1932 by 1932 pixels; color fundus photograph.
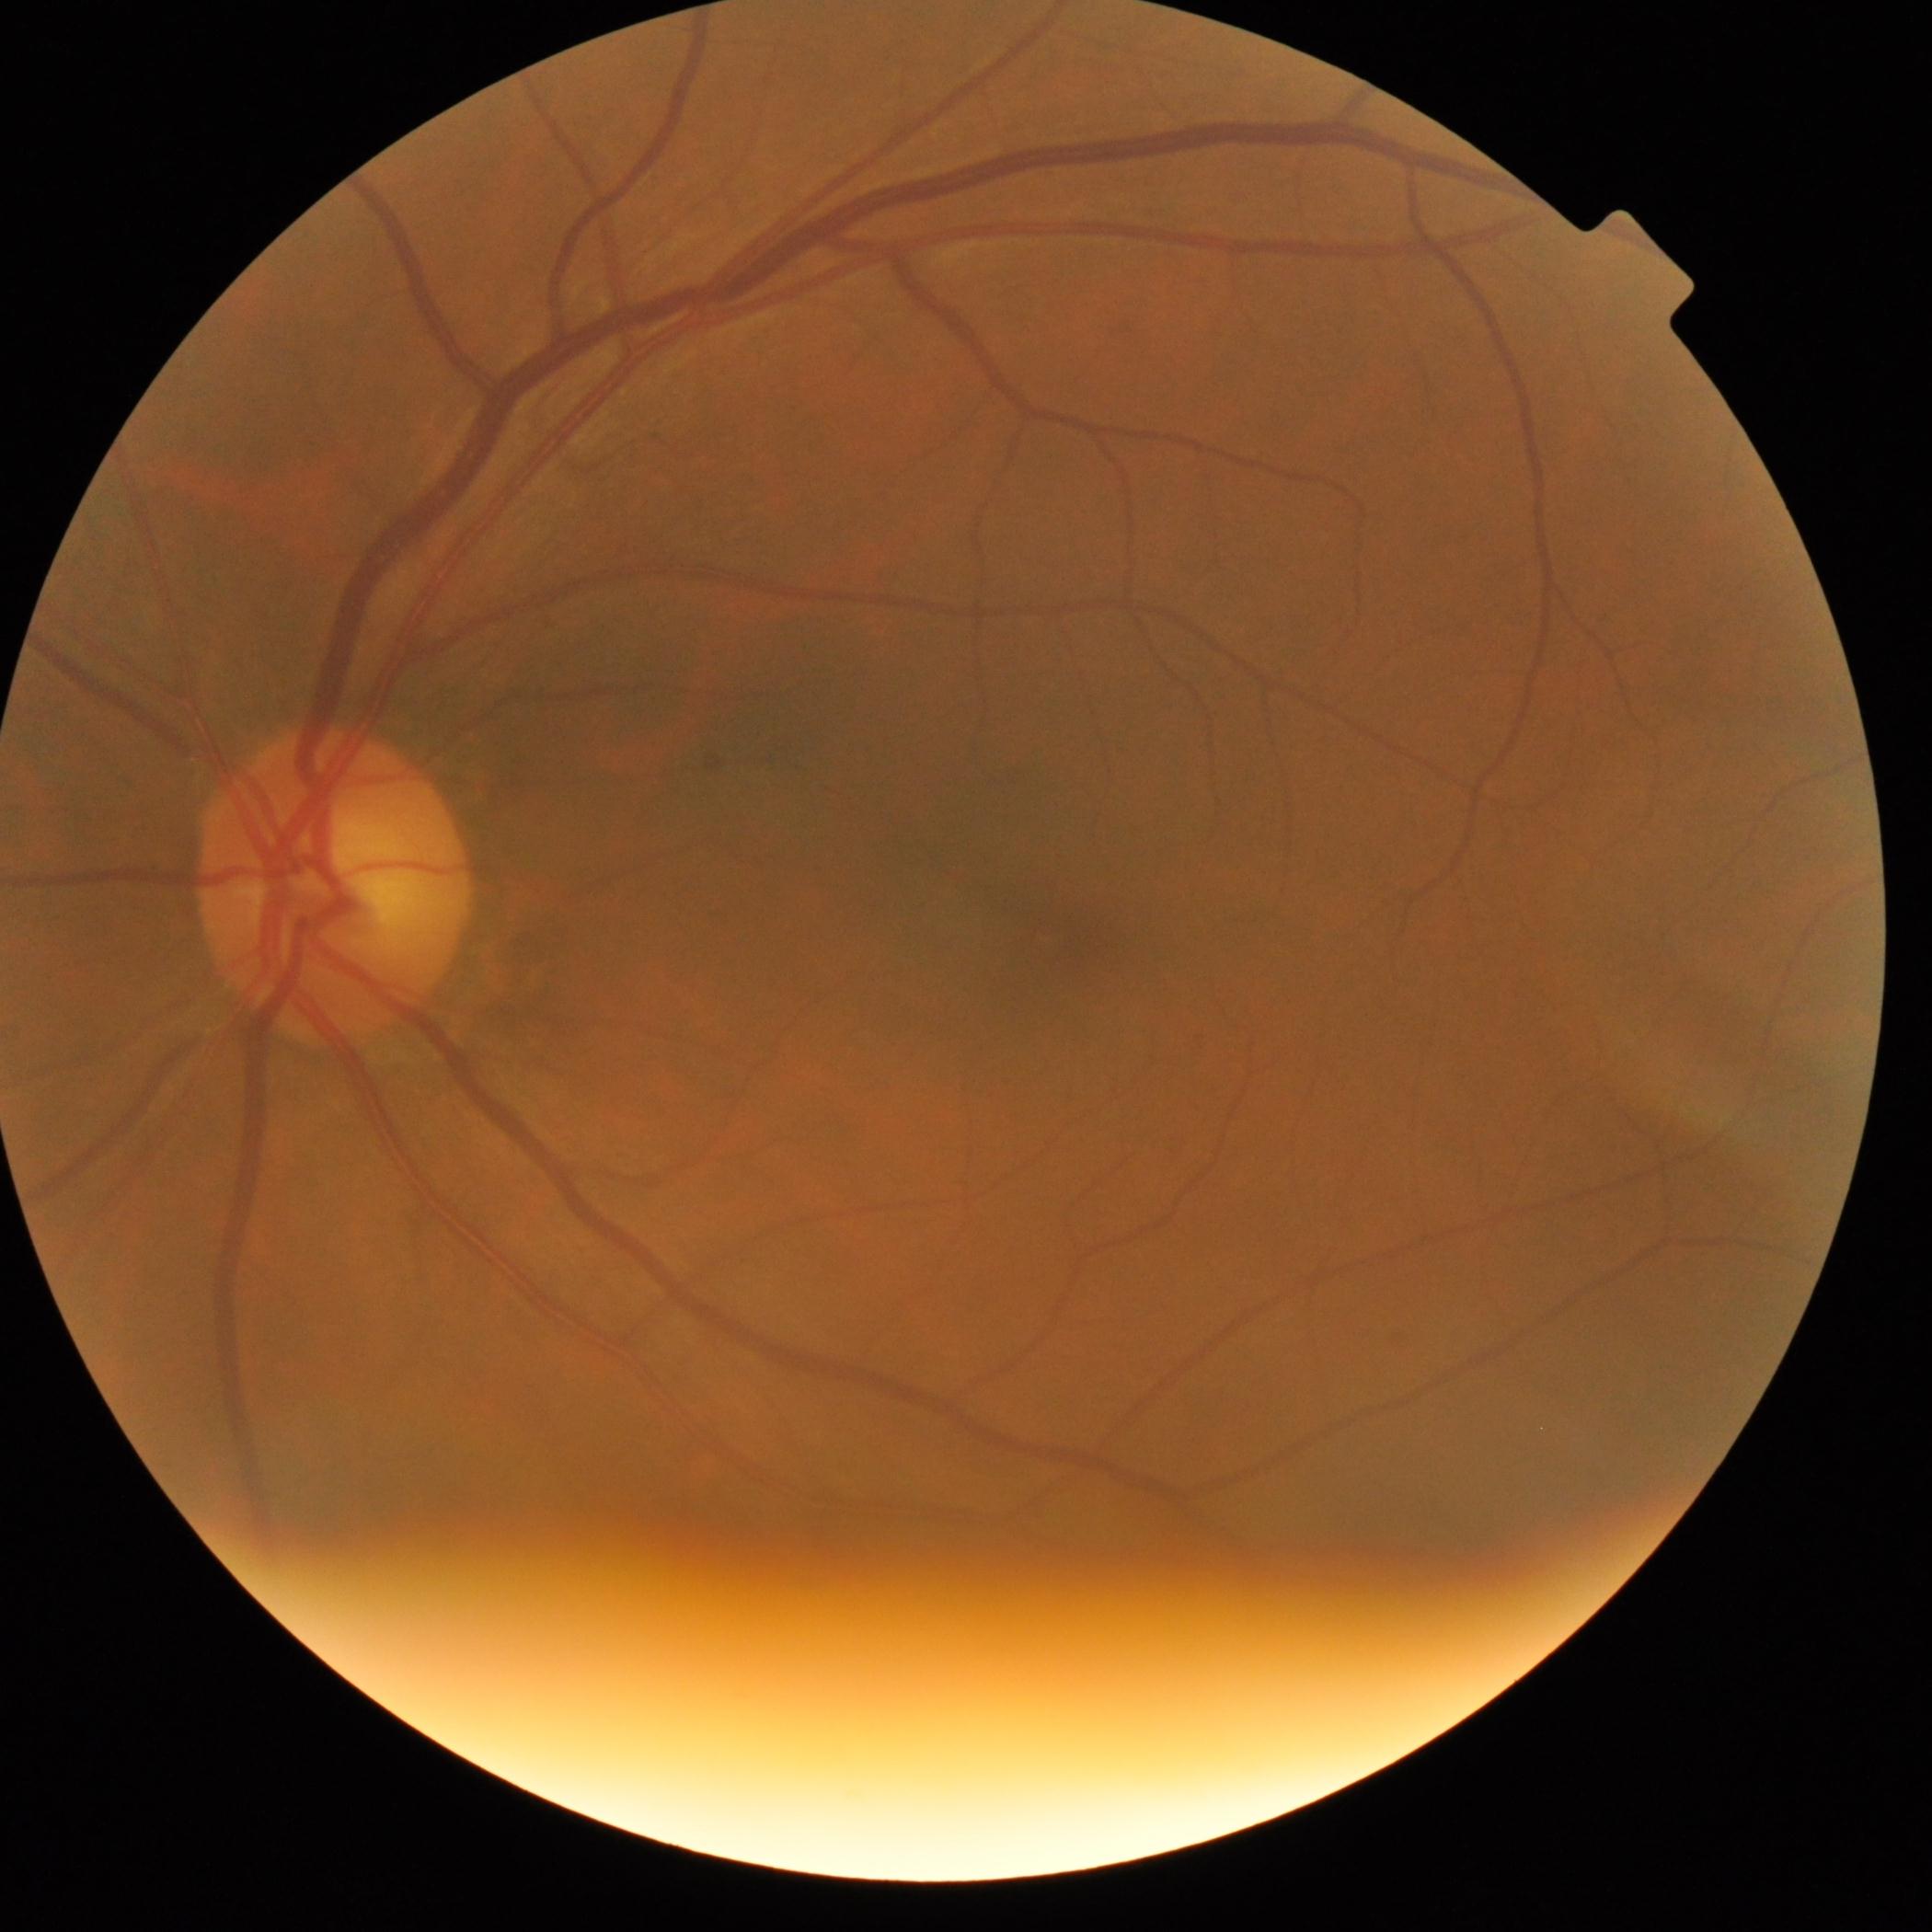
diabetic retinopathy = no apparent diabetic retinopathy (grade 0)